2048x1536px; fundus photo.
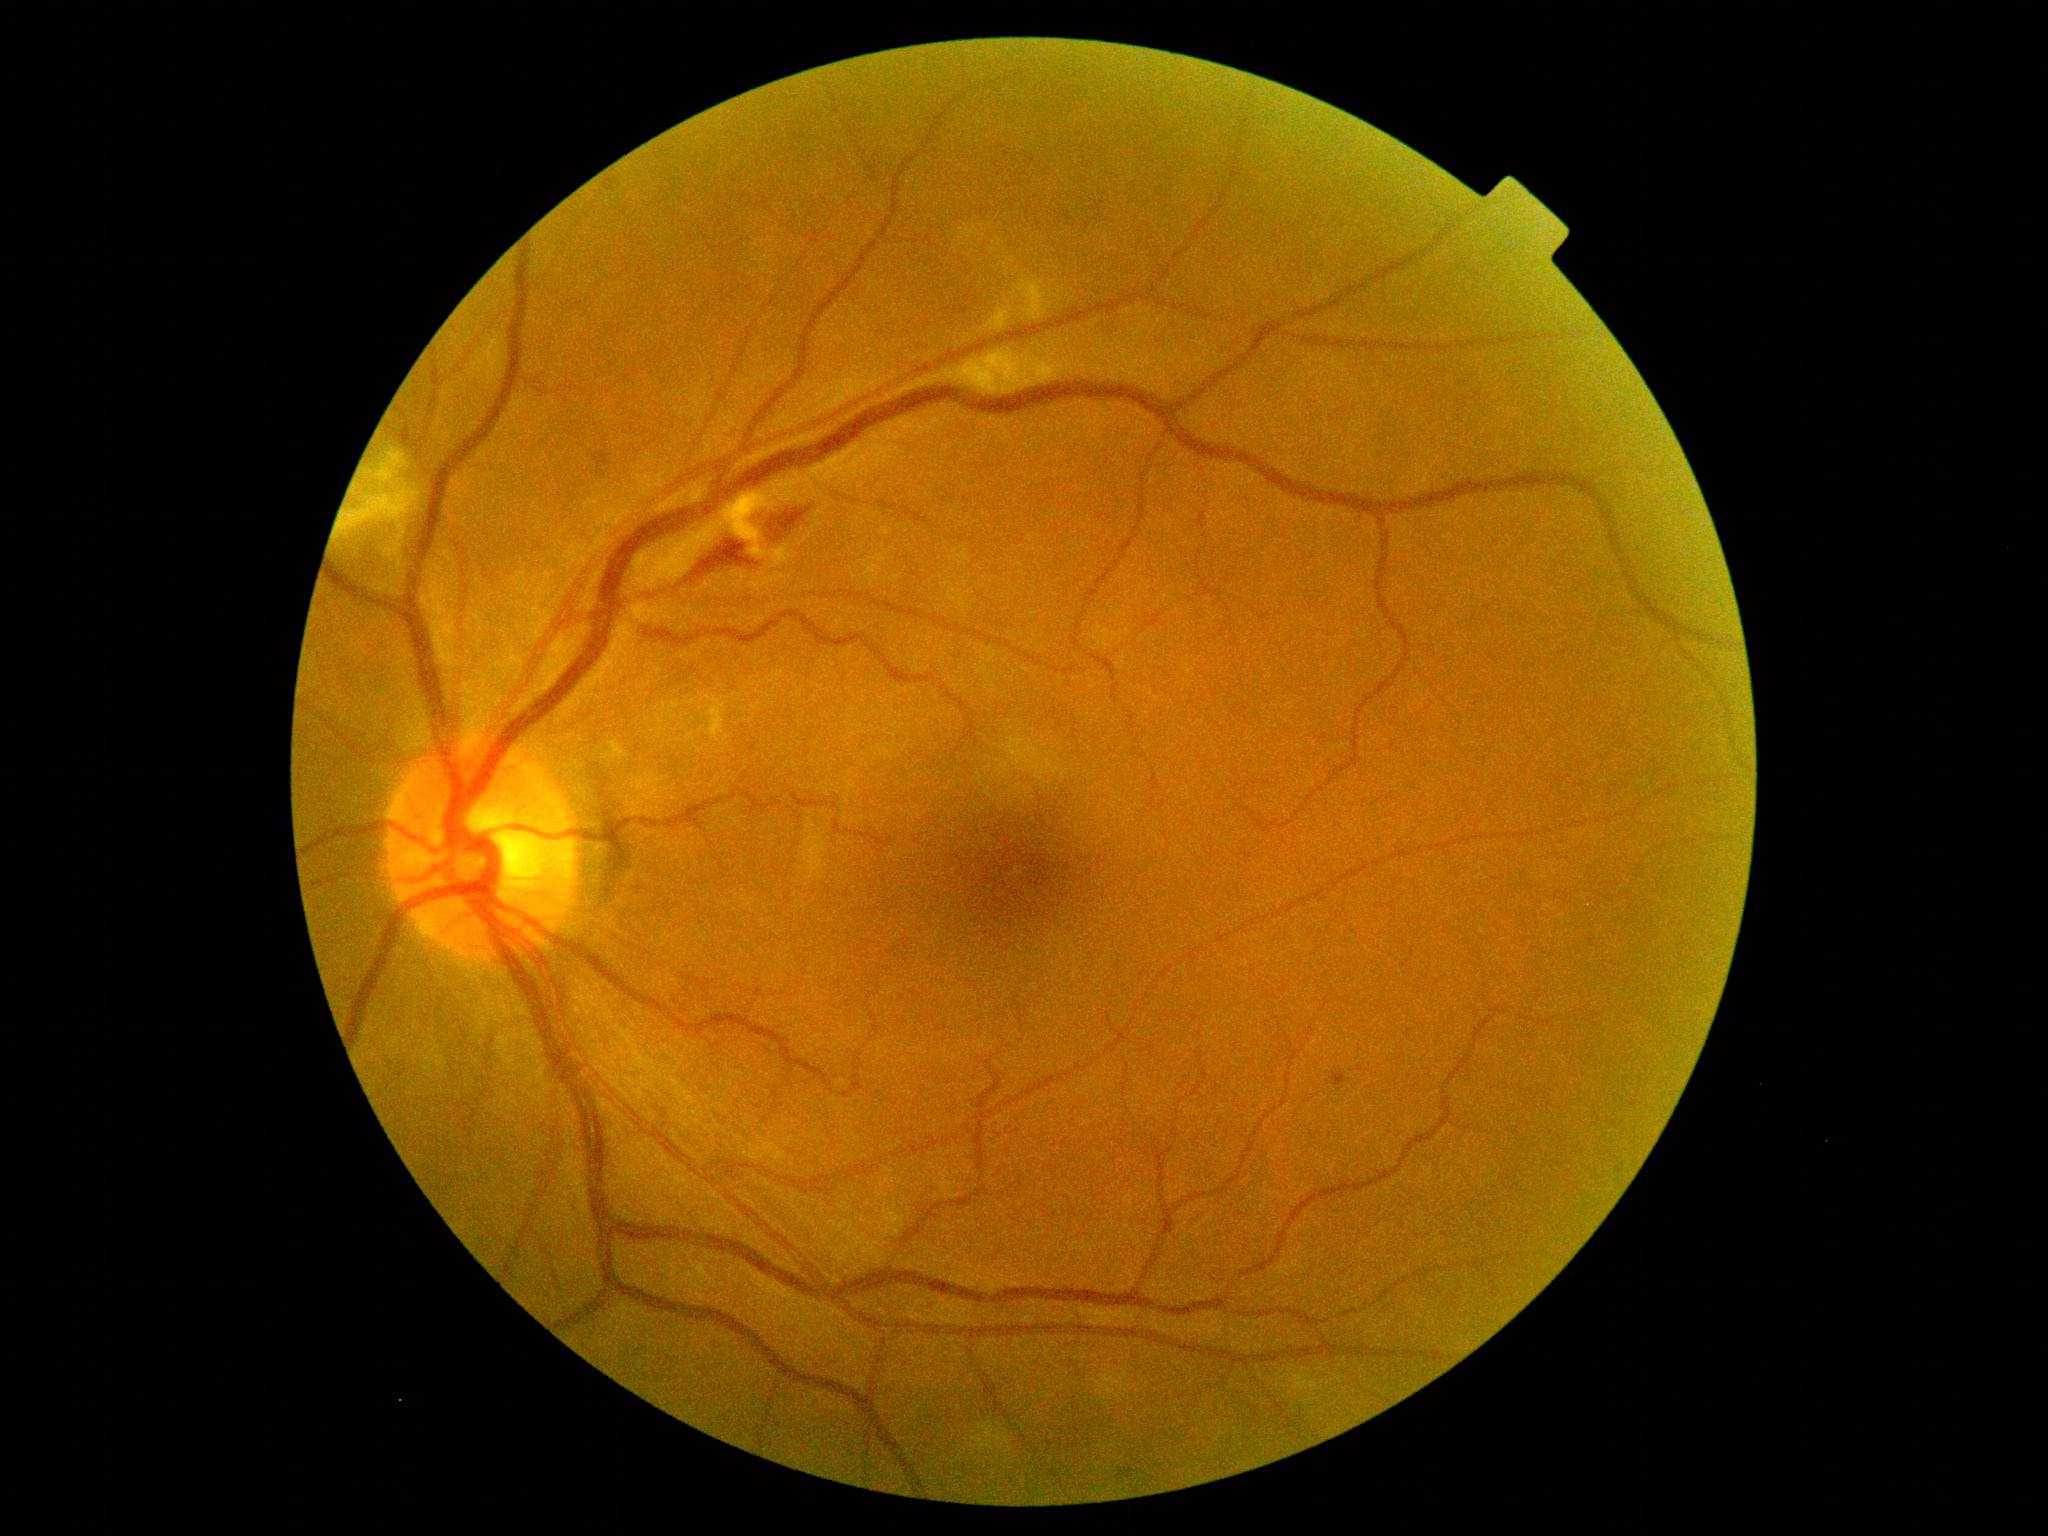

Retinopathy is 2
hard exudates: none identified
soft exudates: Rect(339, 448, 421, 542) | Rect(618, 742, 630, 758) | Rect(1093, 1368, 1133, 1402) | Rect(729, 496, 800, 568) | Rect(1013, 276, 1053, 321) | Rect(965, 351, 1051, 397) | Rect(972, 1421, 1011, 1452) | Rect(370, 543, 404, 596) | Rect(987, 308, 1012, 332) | Rect(701, 694, 726, 742)
hemorrhages: Rect(686, 539, 759, 585) | Rect(594, 452, 611, 467) | Rect(769, 507, 812, 543)
microaneurysms: Rect(1333, 1072, 1347, 1087)